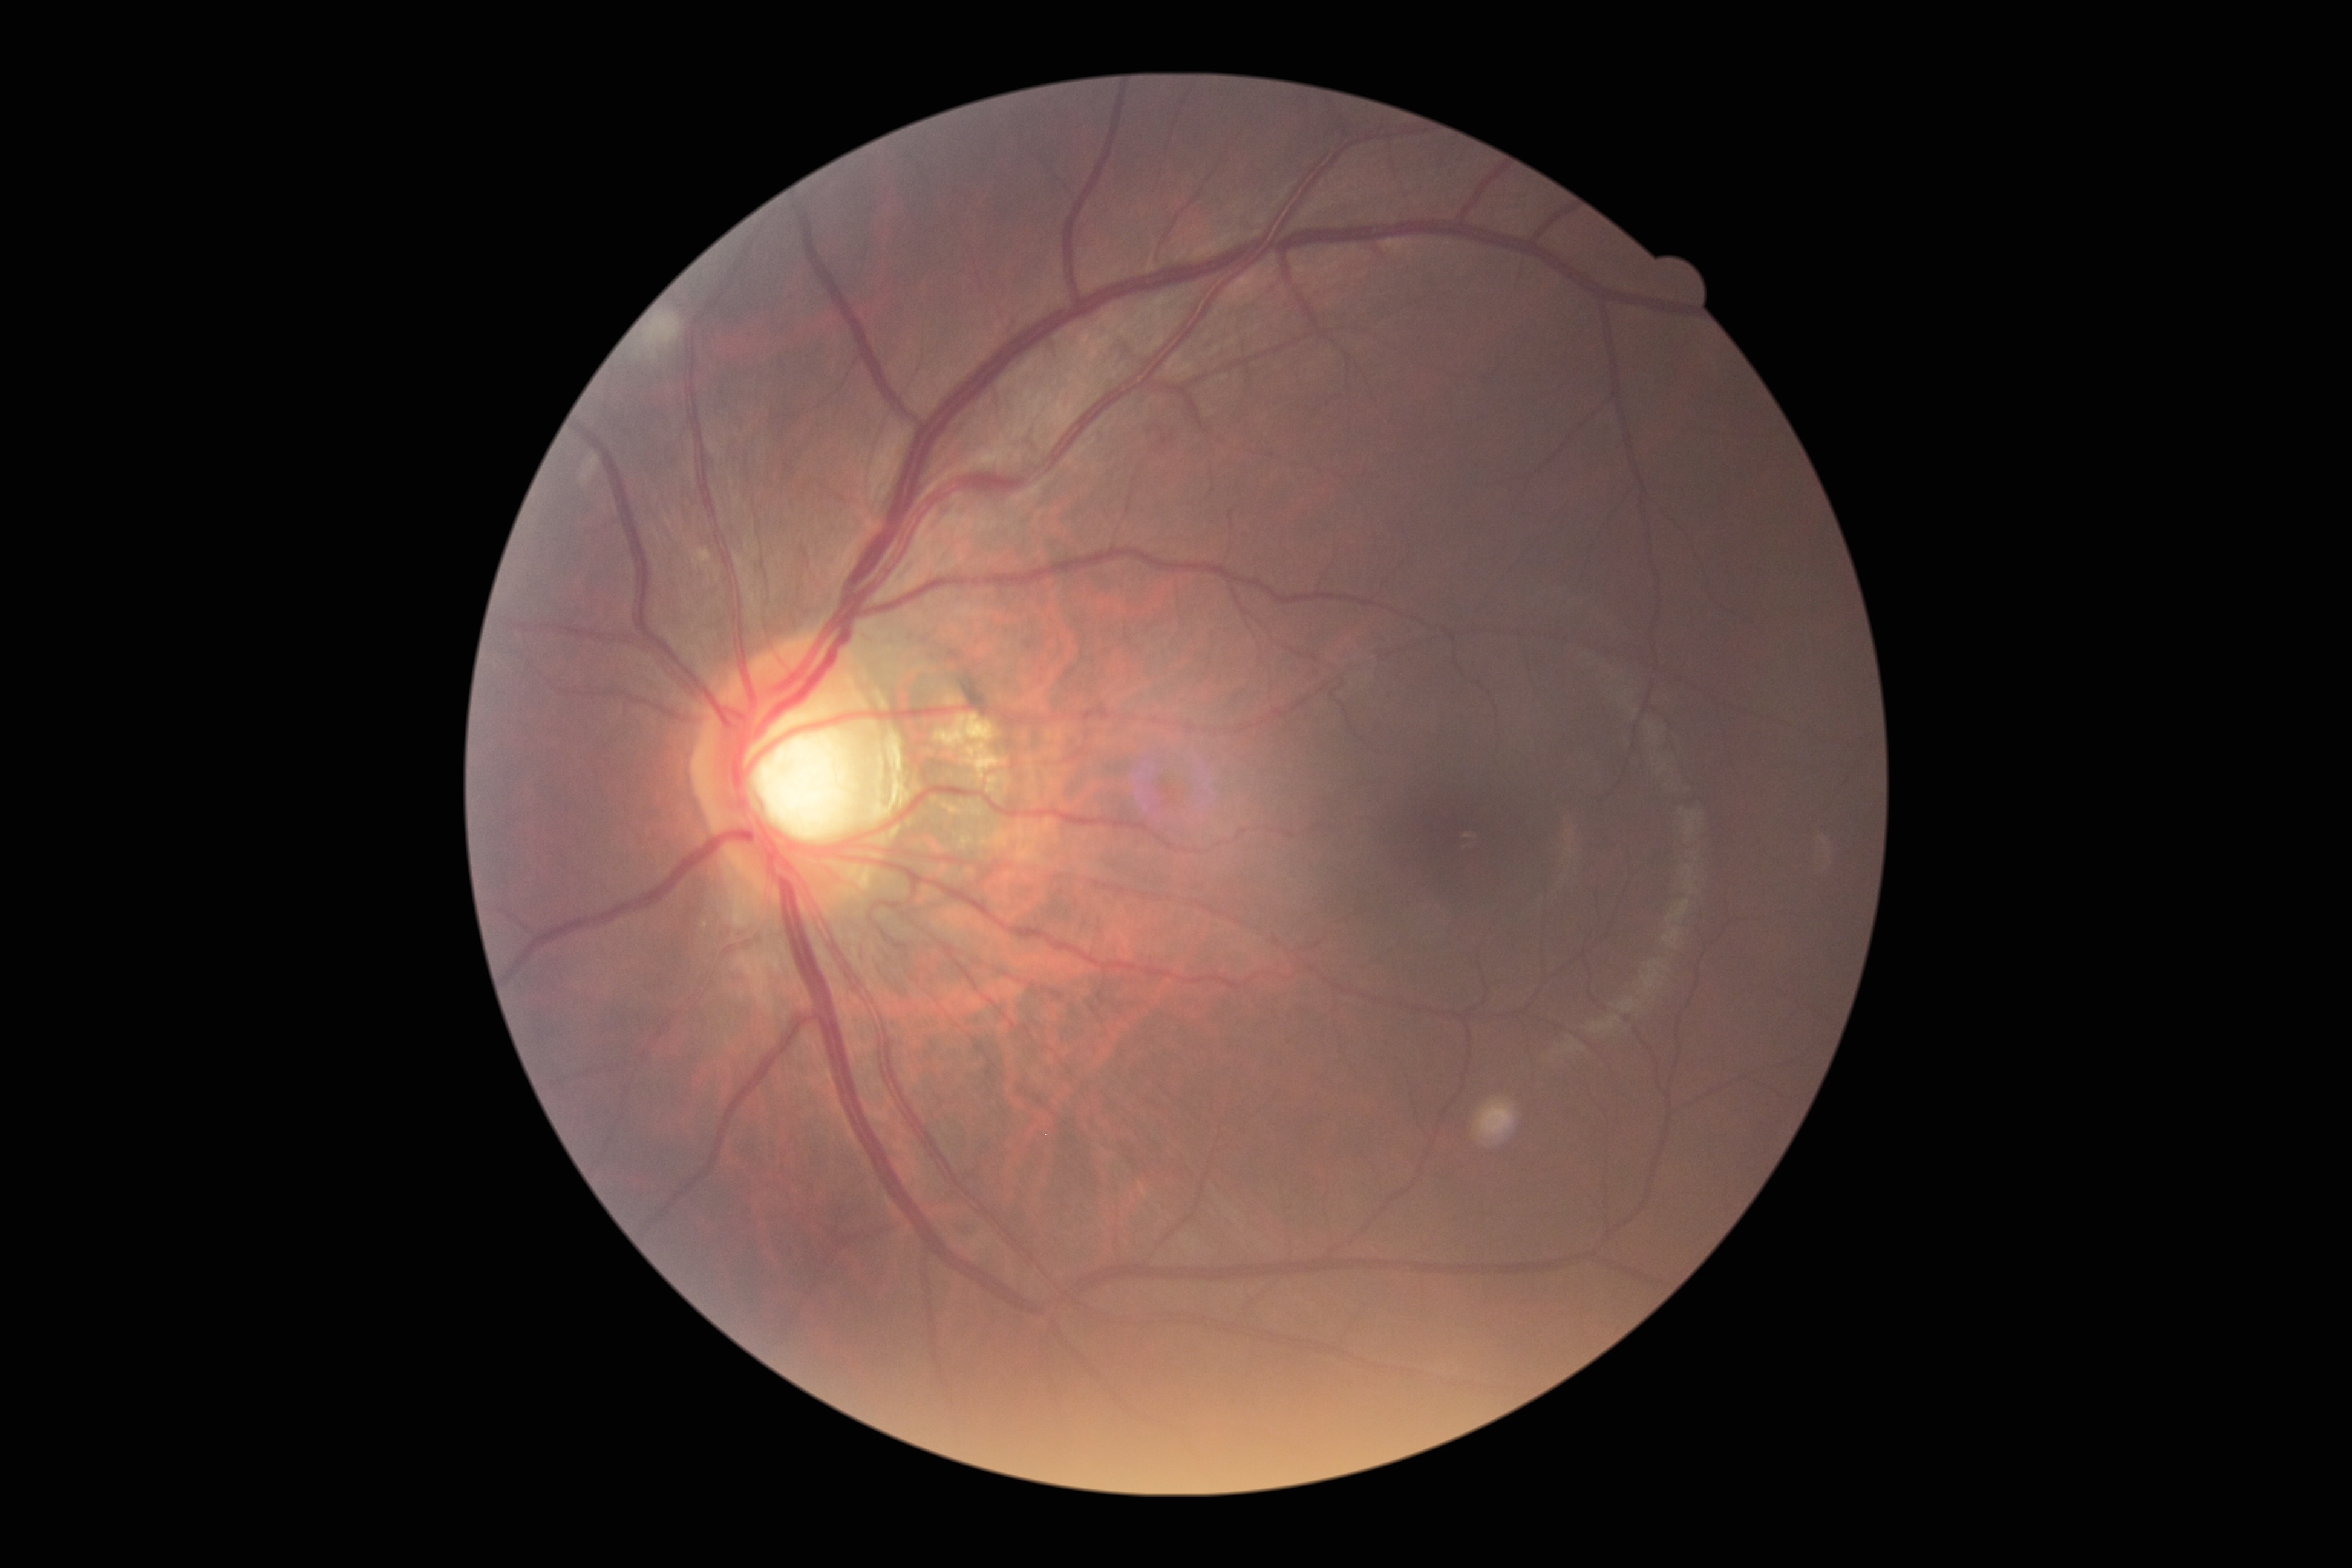
Retinopathy grade is 2 (moderate NPDR).